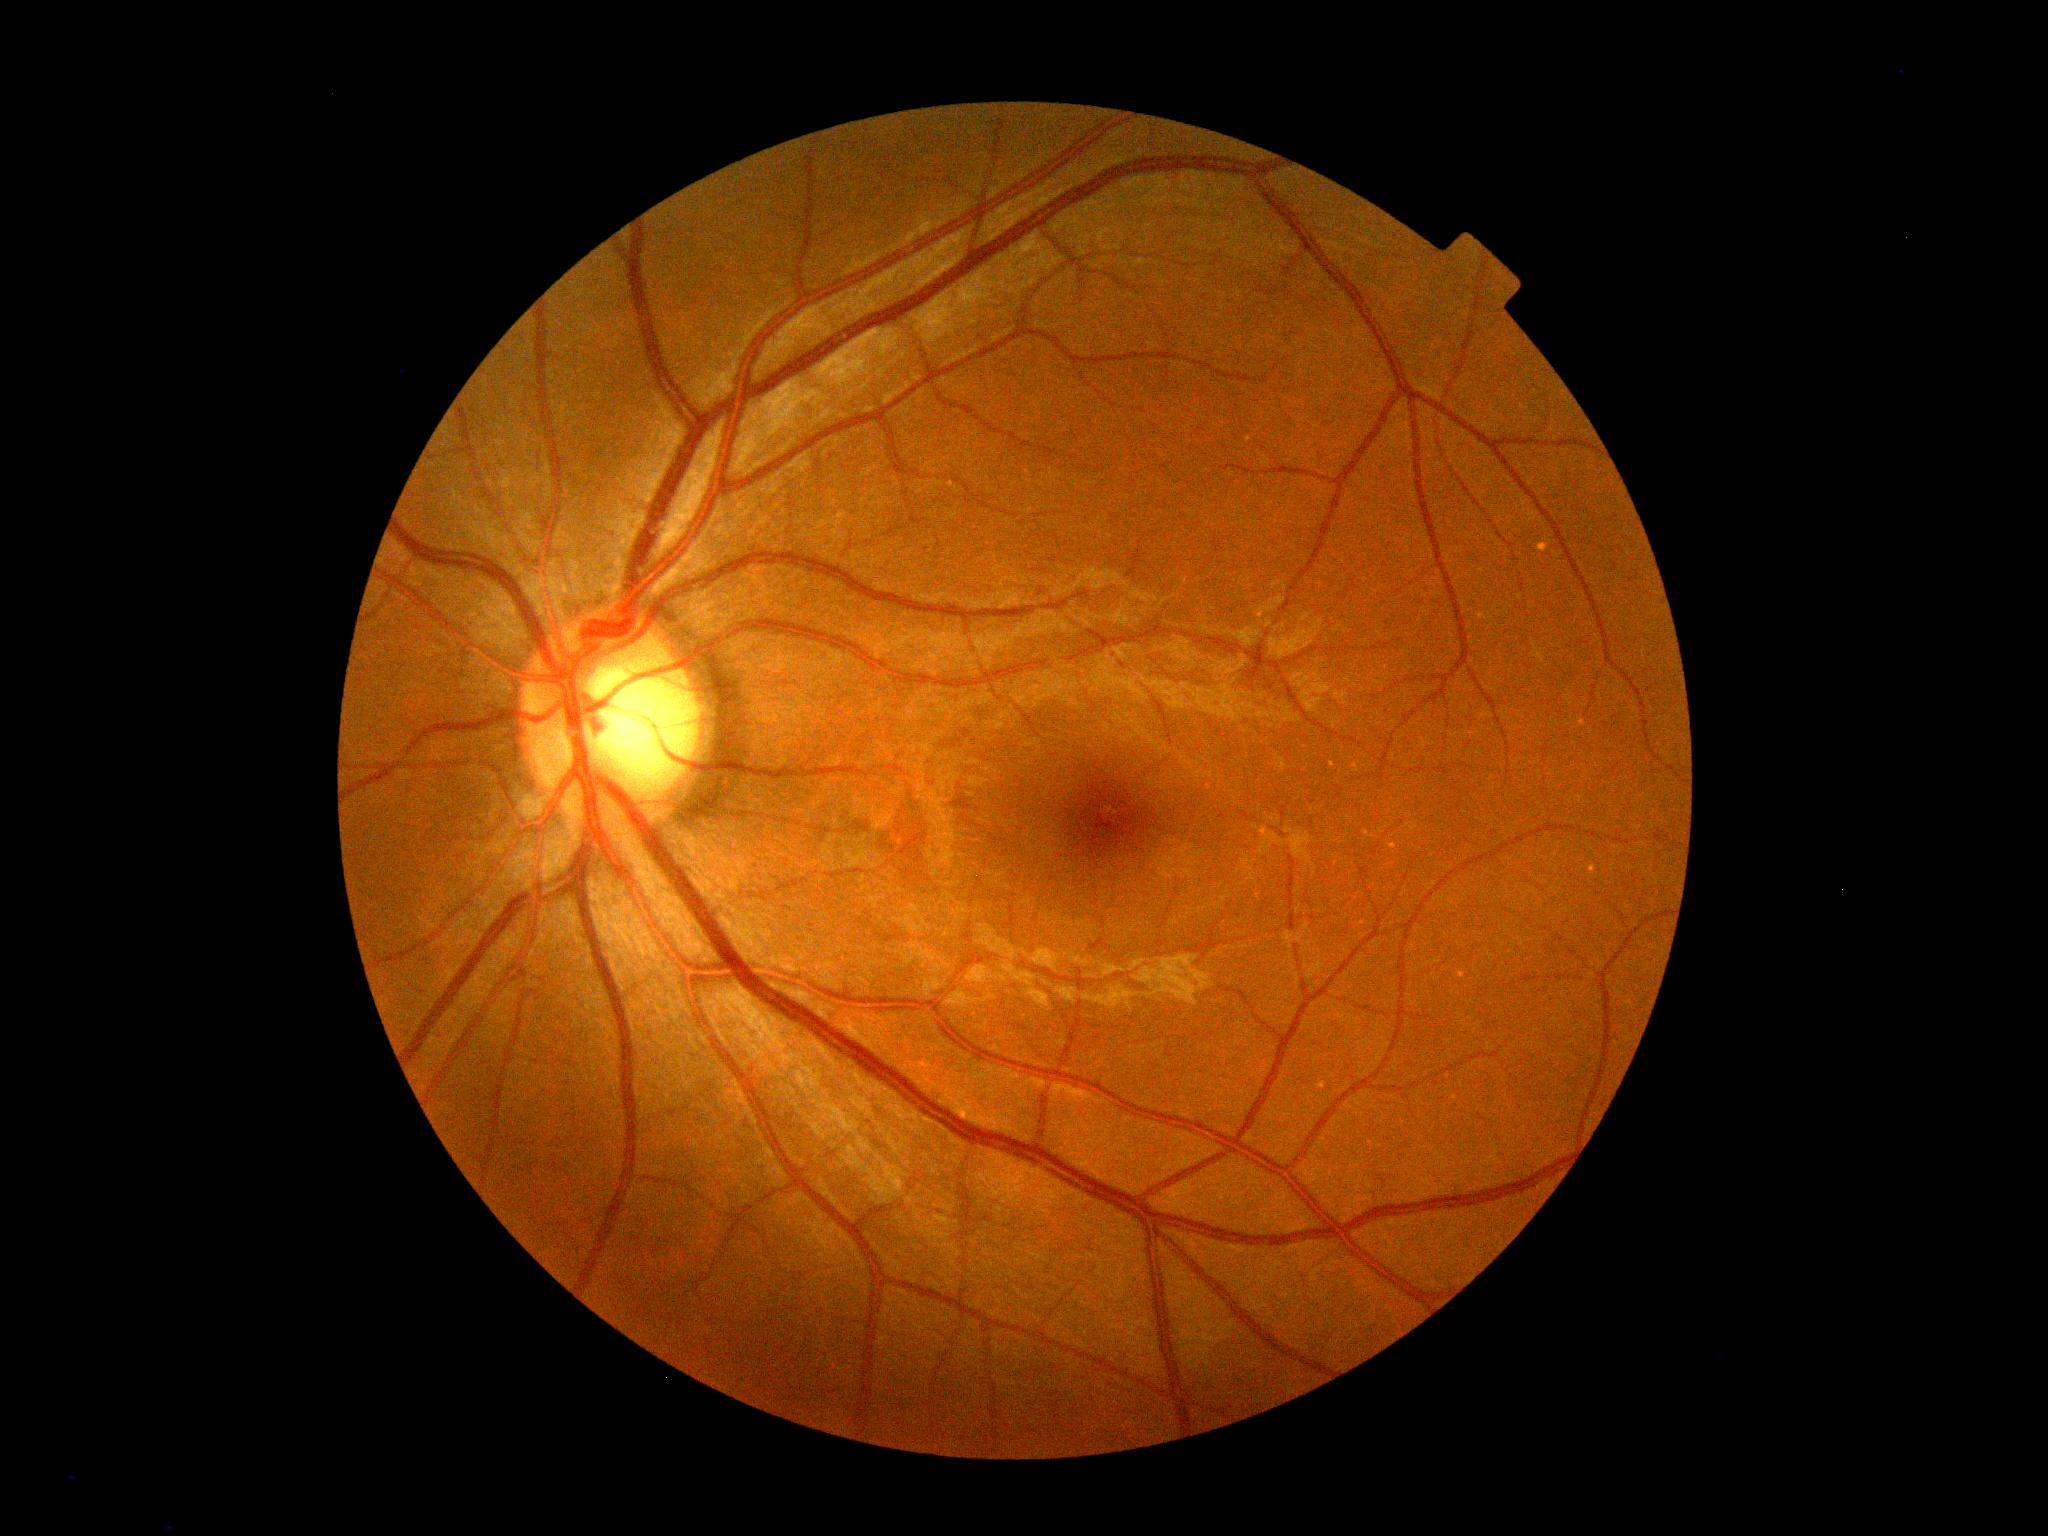

Diabetic retinopathy severity: grade 0 (no apparent retinopathy) — no visible signs of diabetic retinopathy.